Retinal fundus photograph
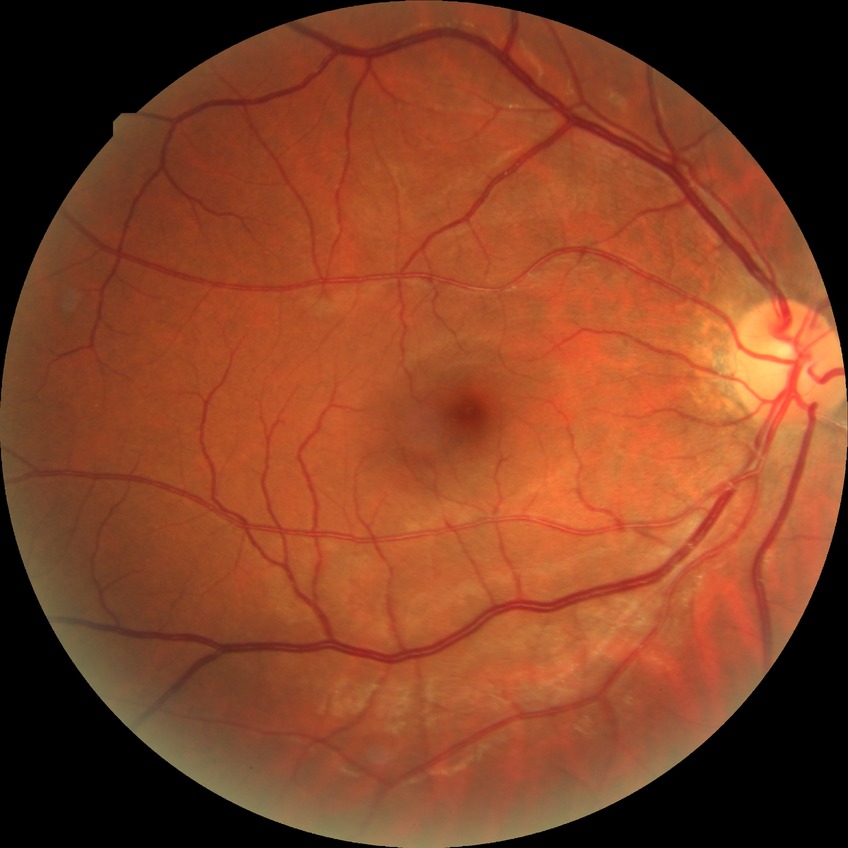

diabetic retinopathy (DR) = NDR (no diabetic retinopathy).